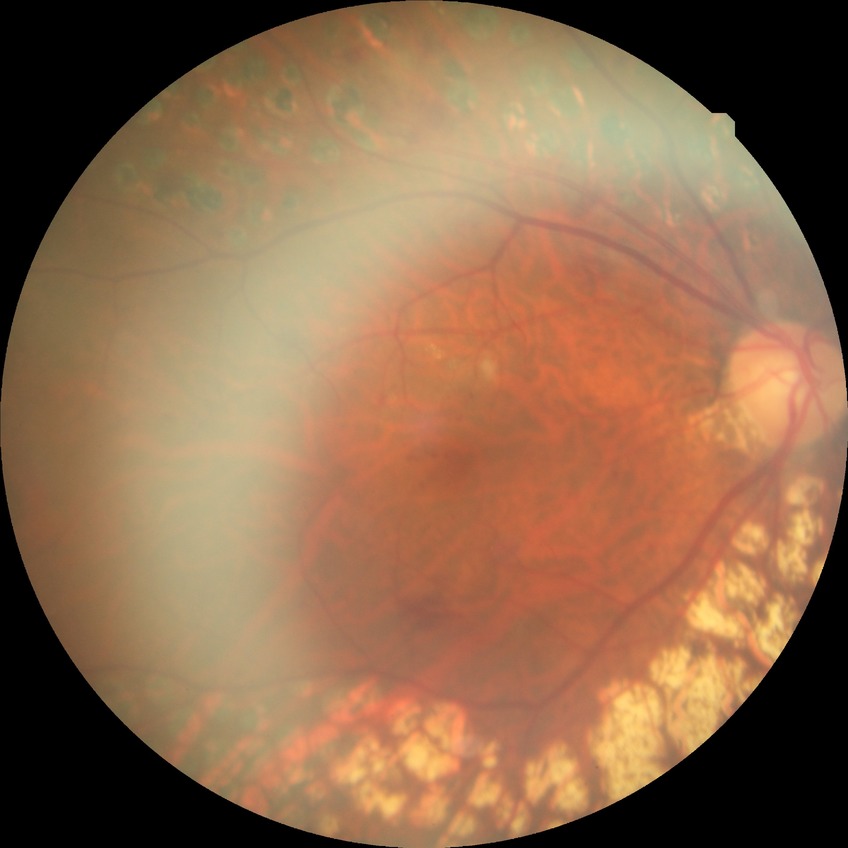 Diabetic retinopathy severity: proliferative diabetic retinopathy.